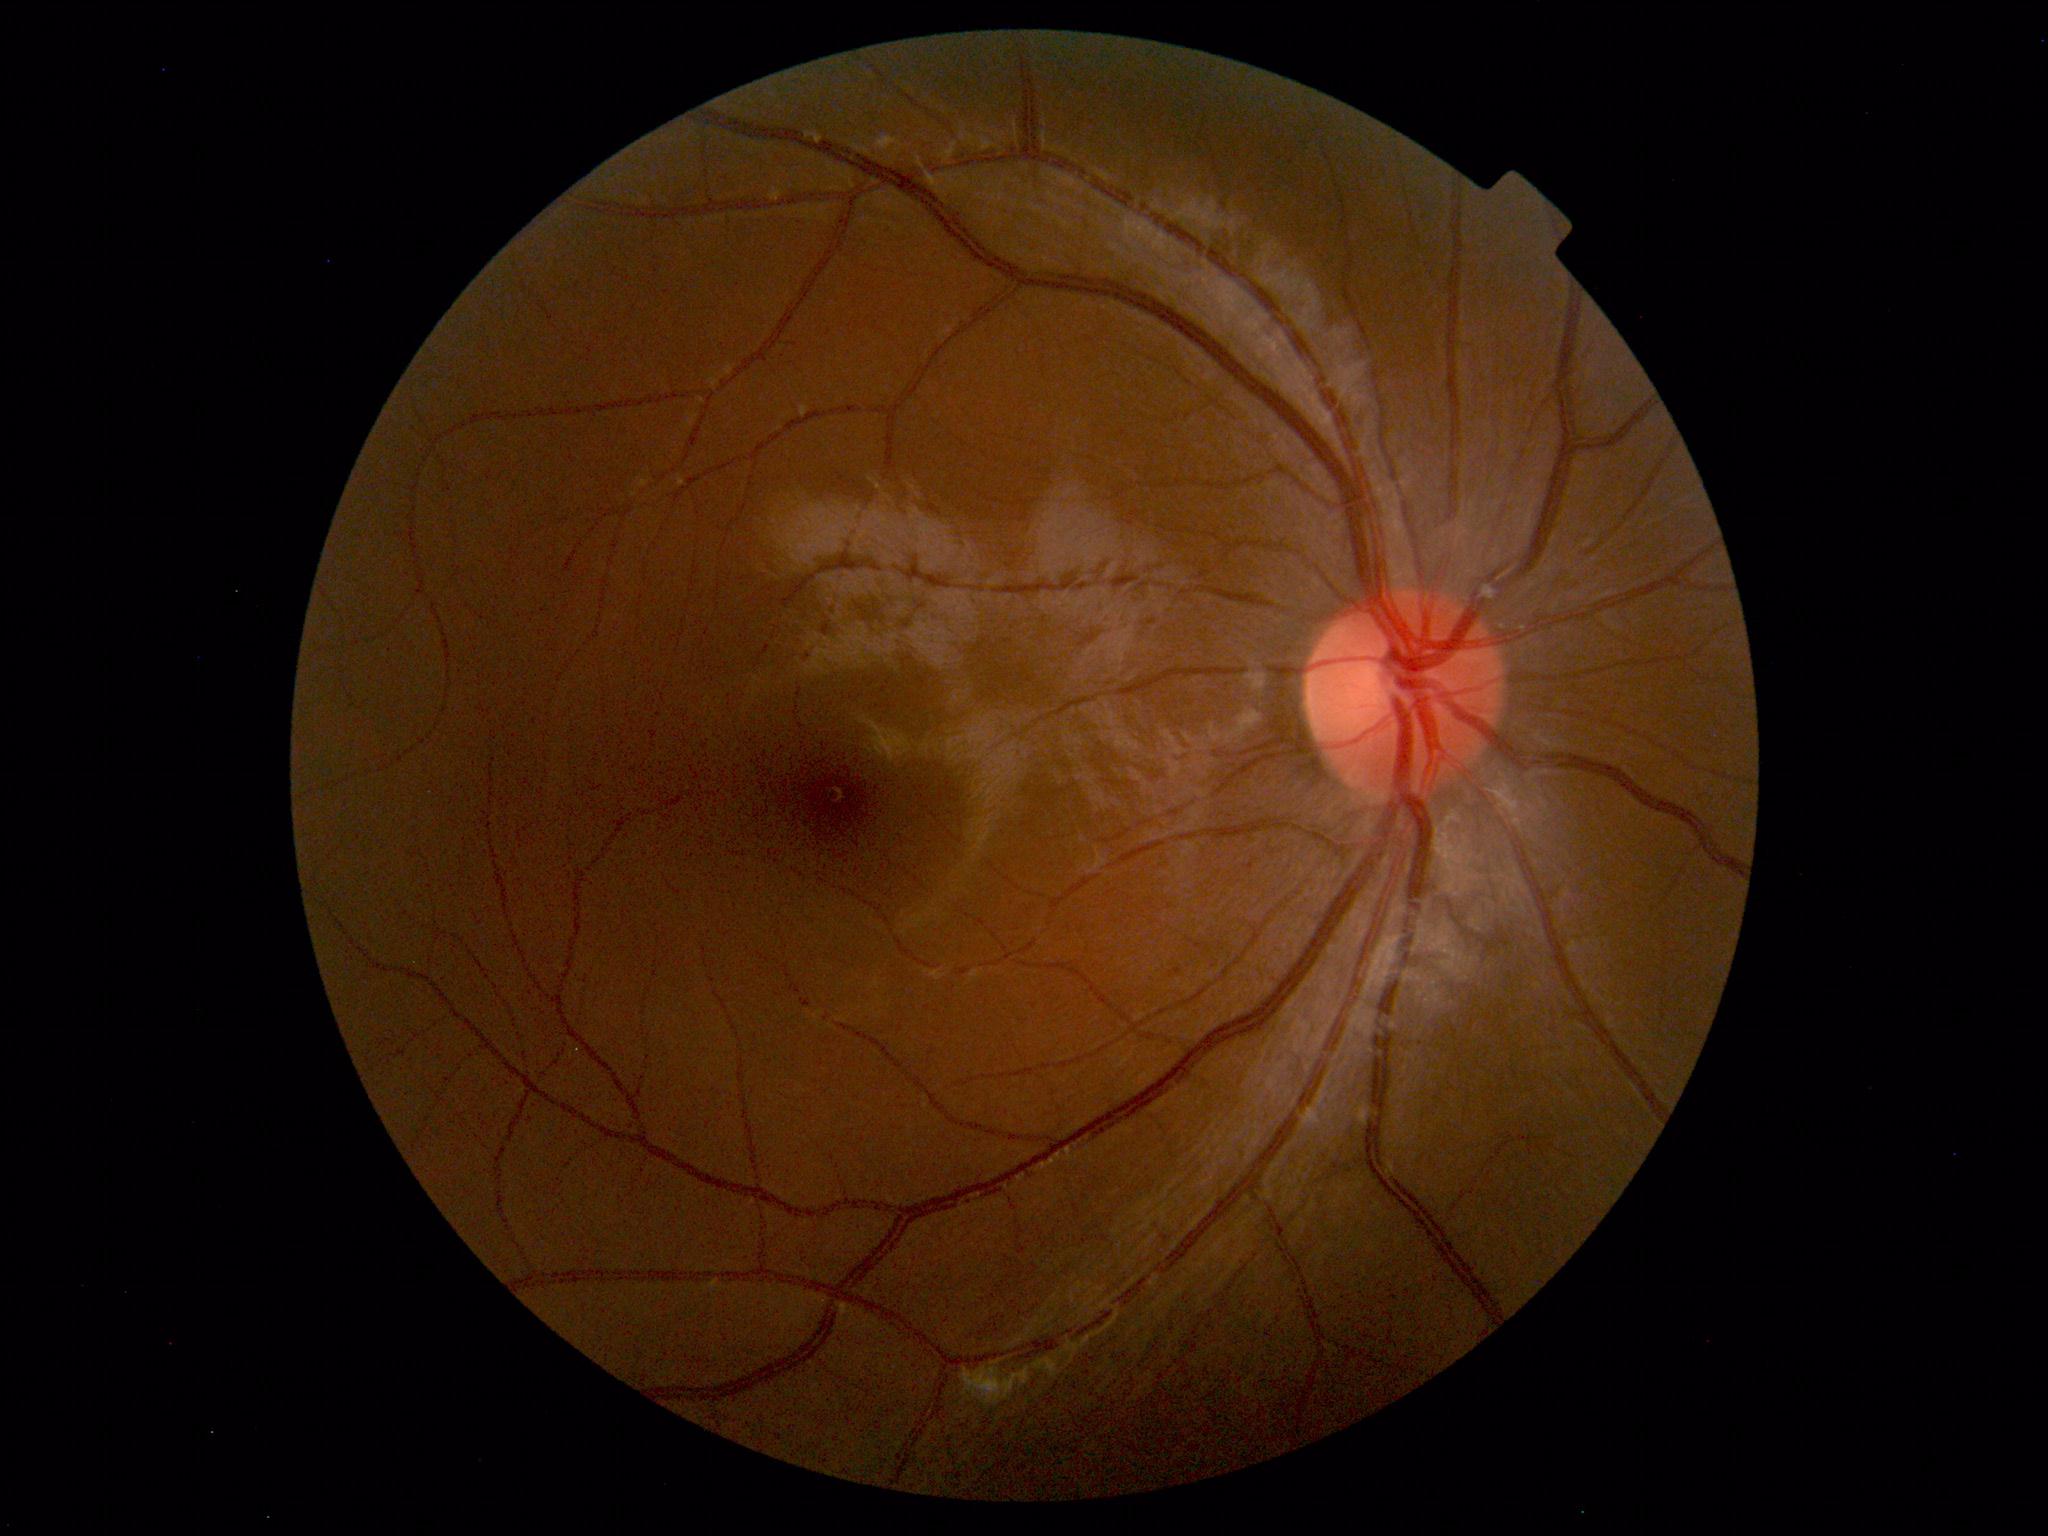 Findings: none. Normal fundus.